Retinal fundus photograph:
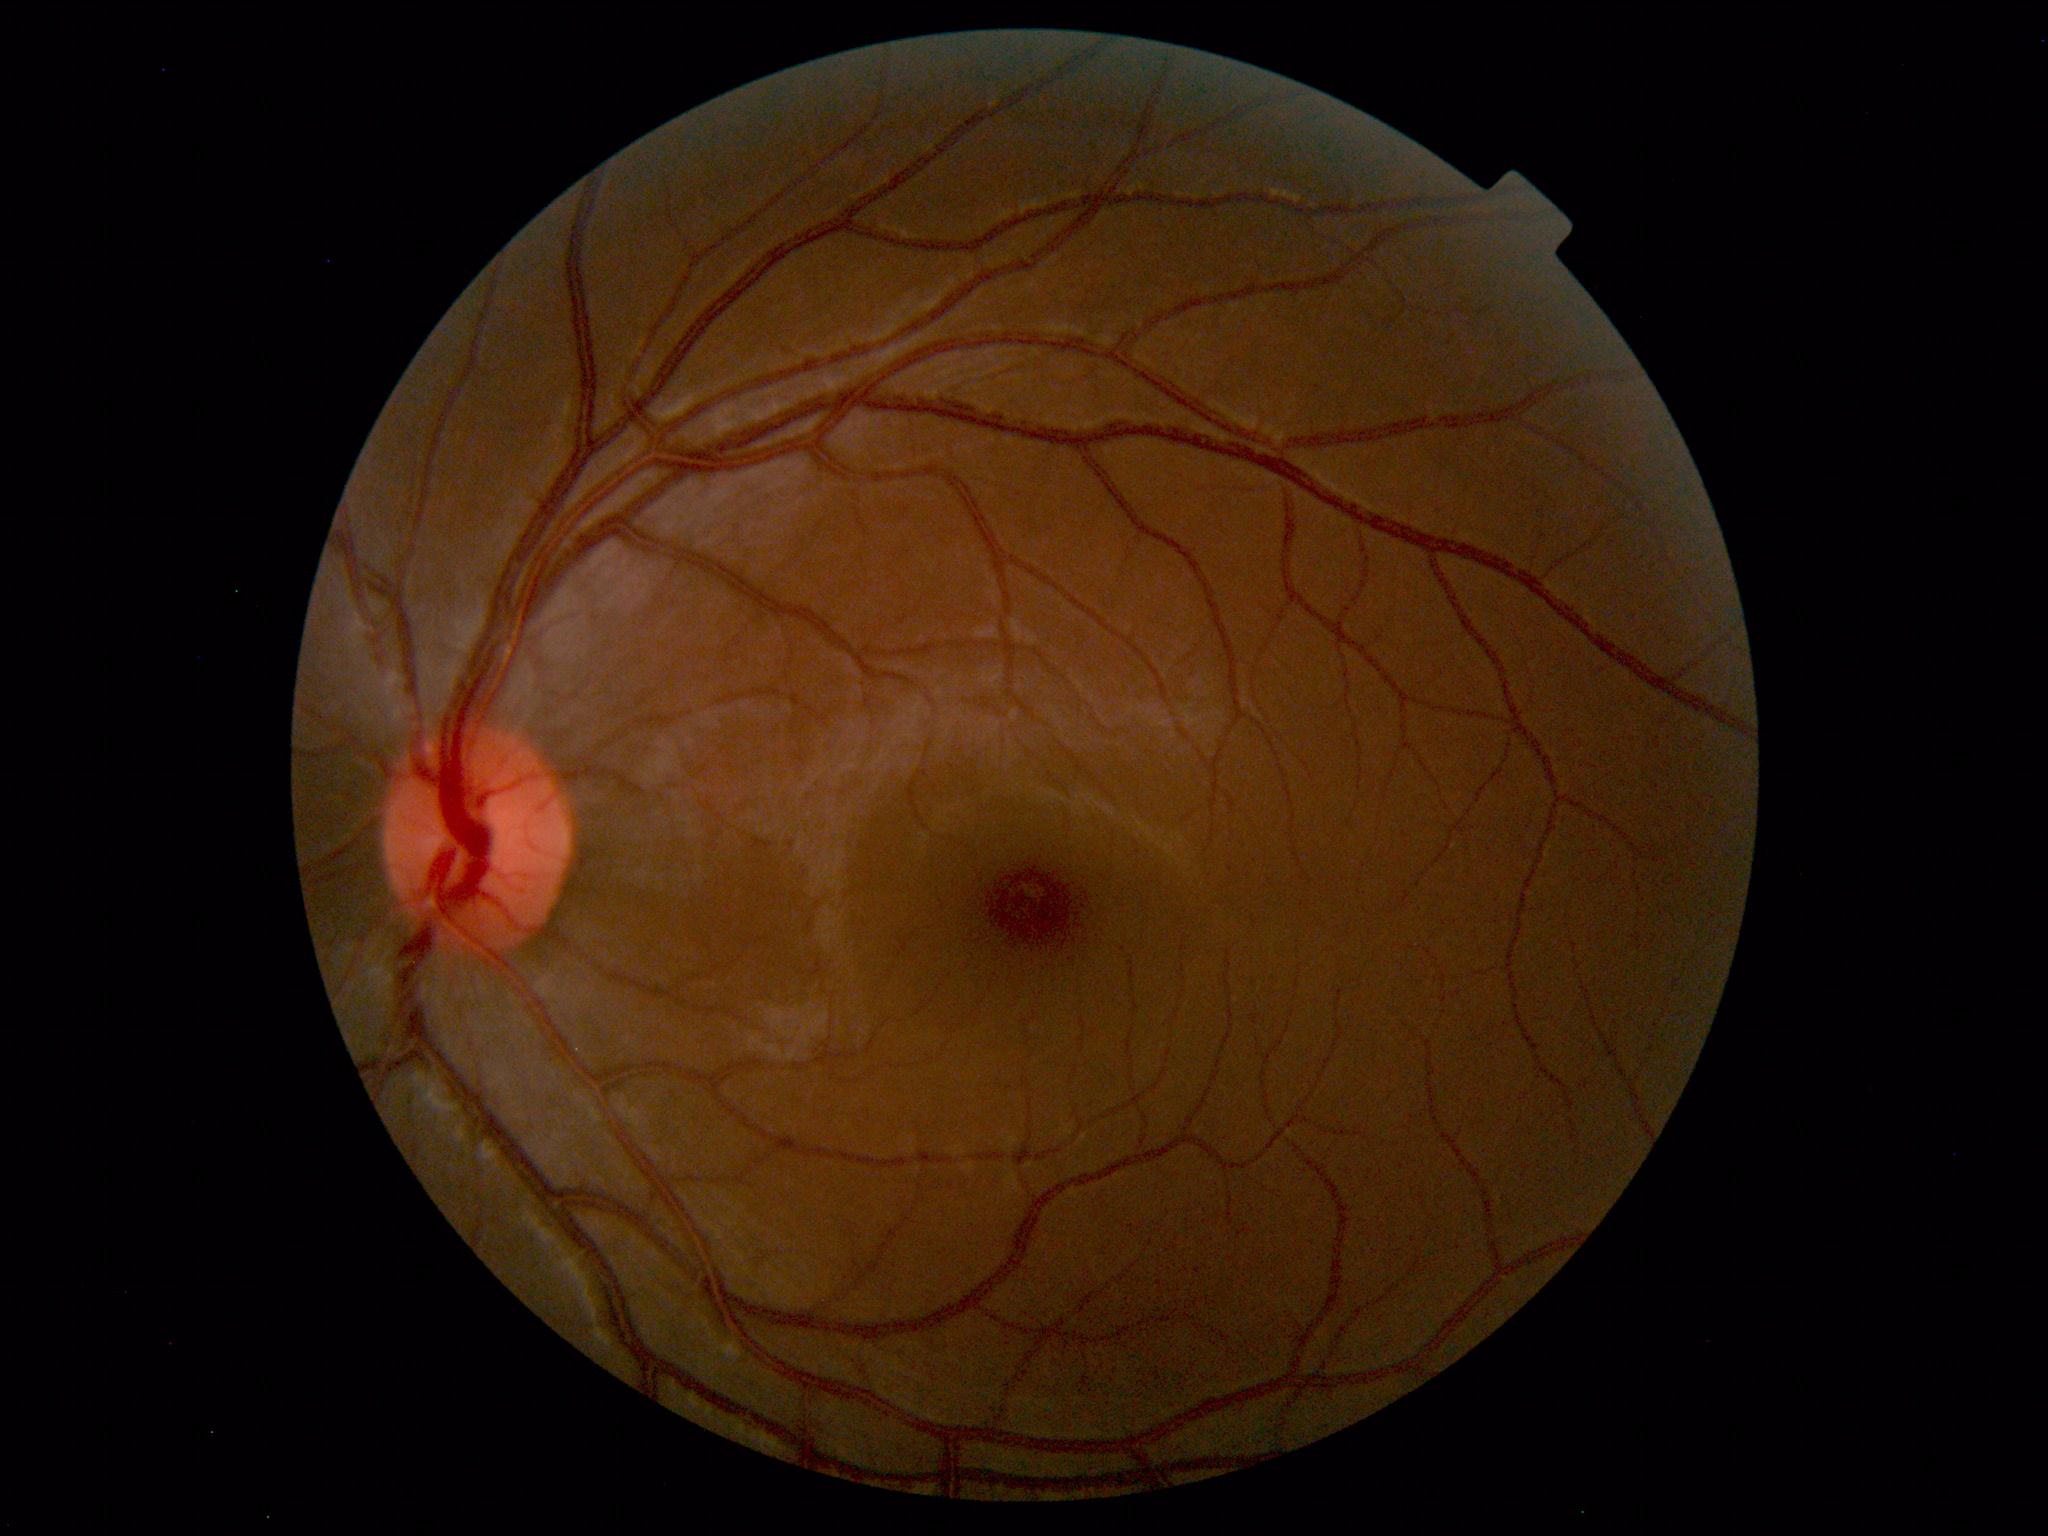

No retinal pathology identified.